Fundus photo · FOV: 45 degrees:
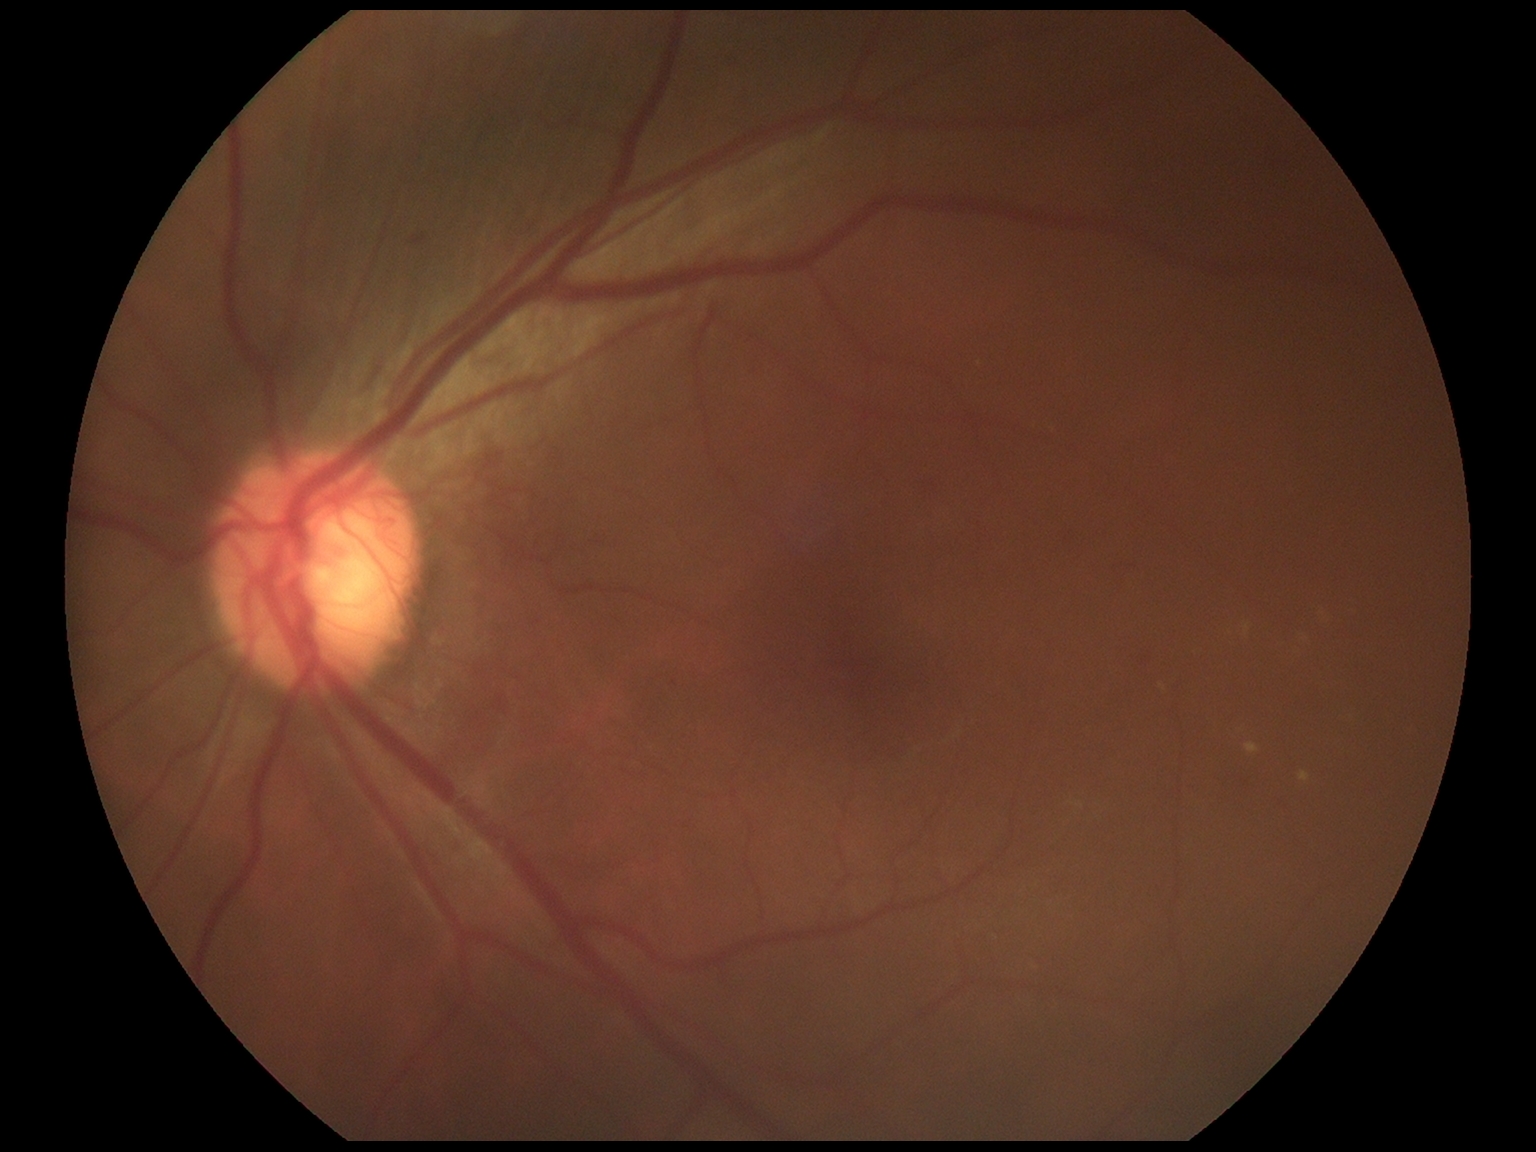

Diabetic retinopathy: grade 2.